Topcon TRC-50DX, captured after pupil dilation, retinal fundus photograph, 50° field of view: 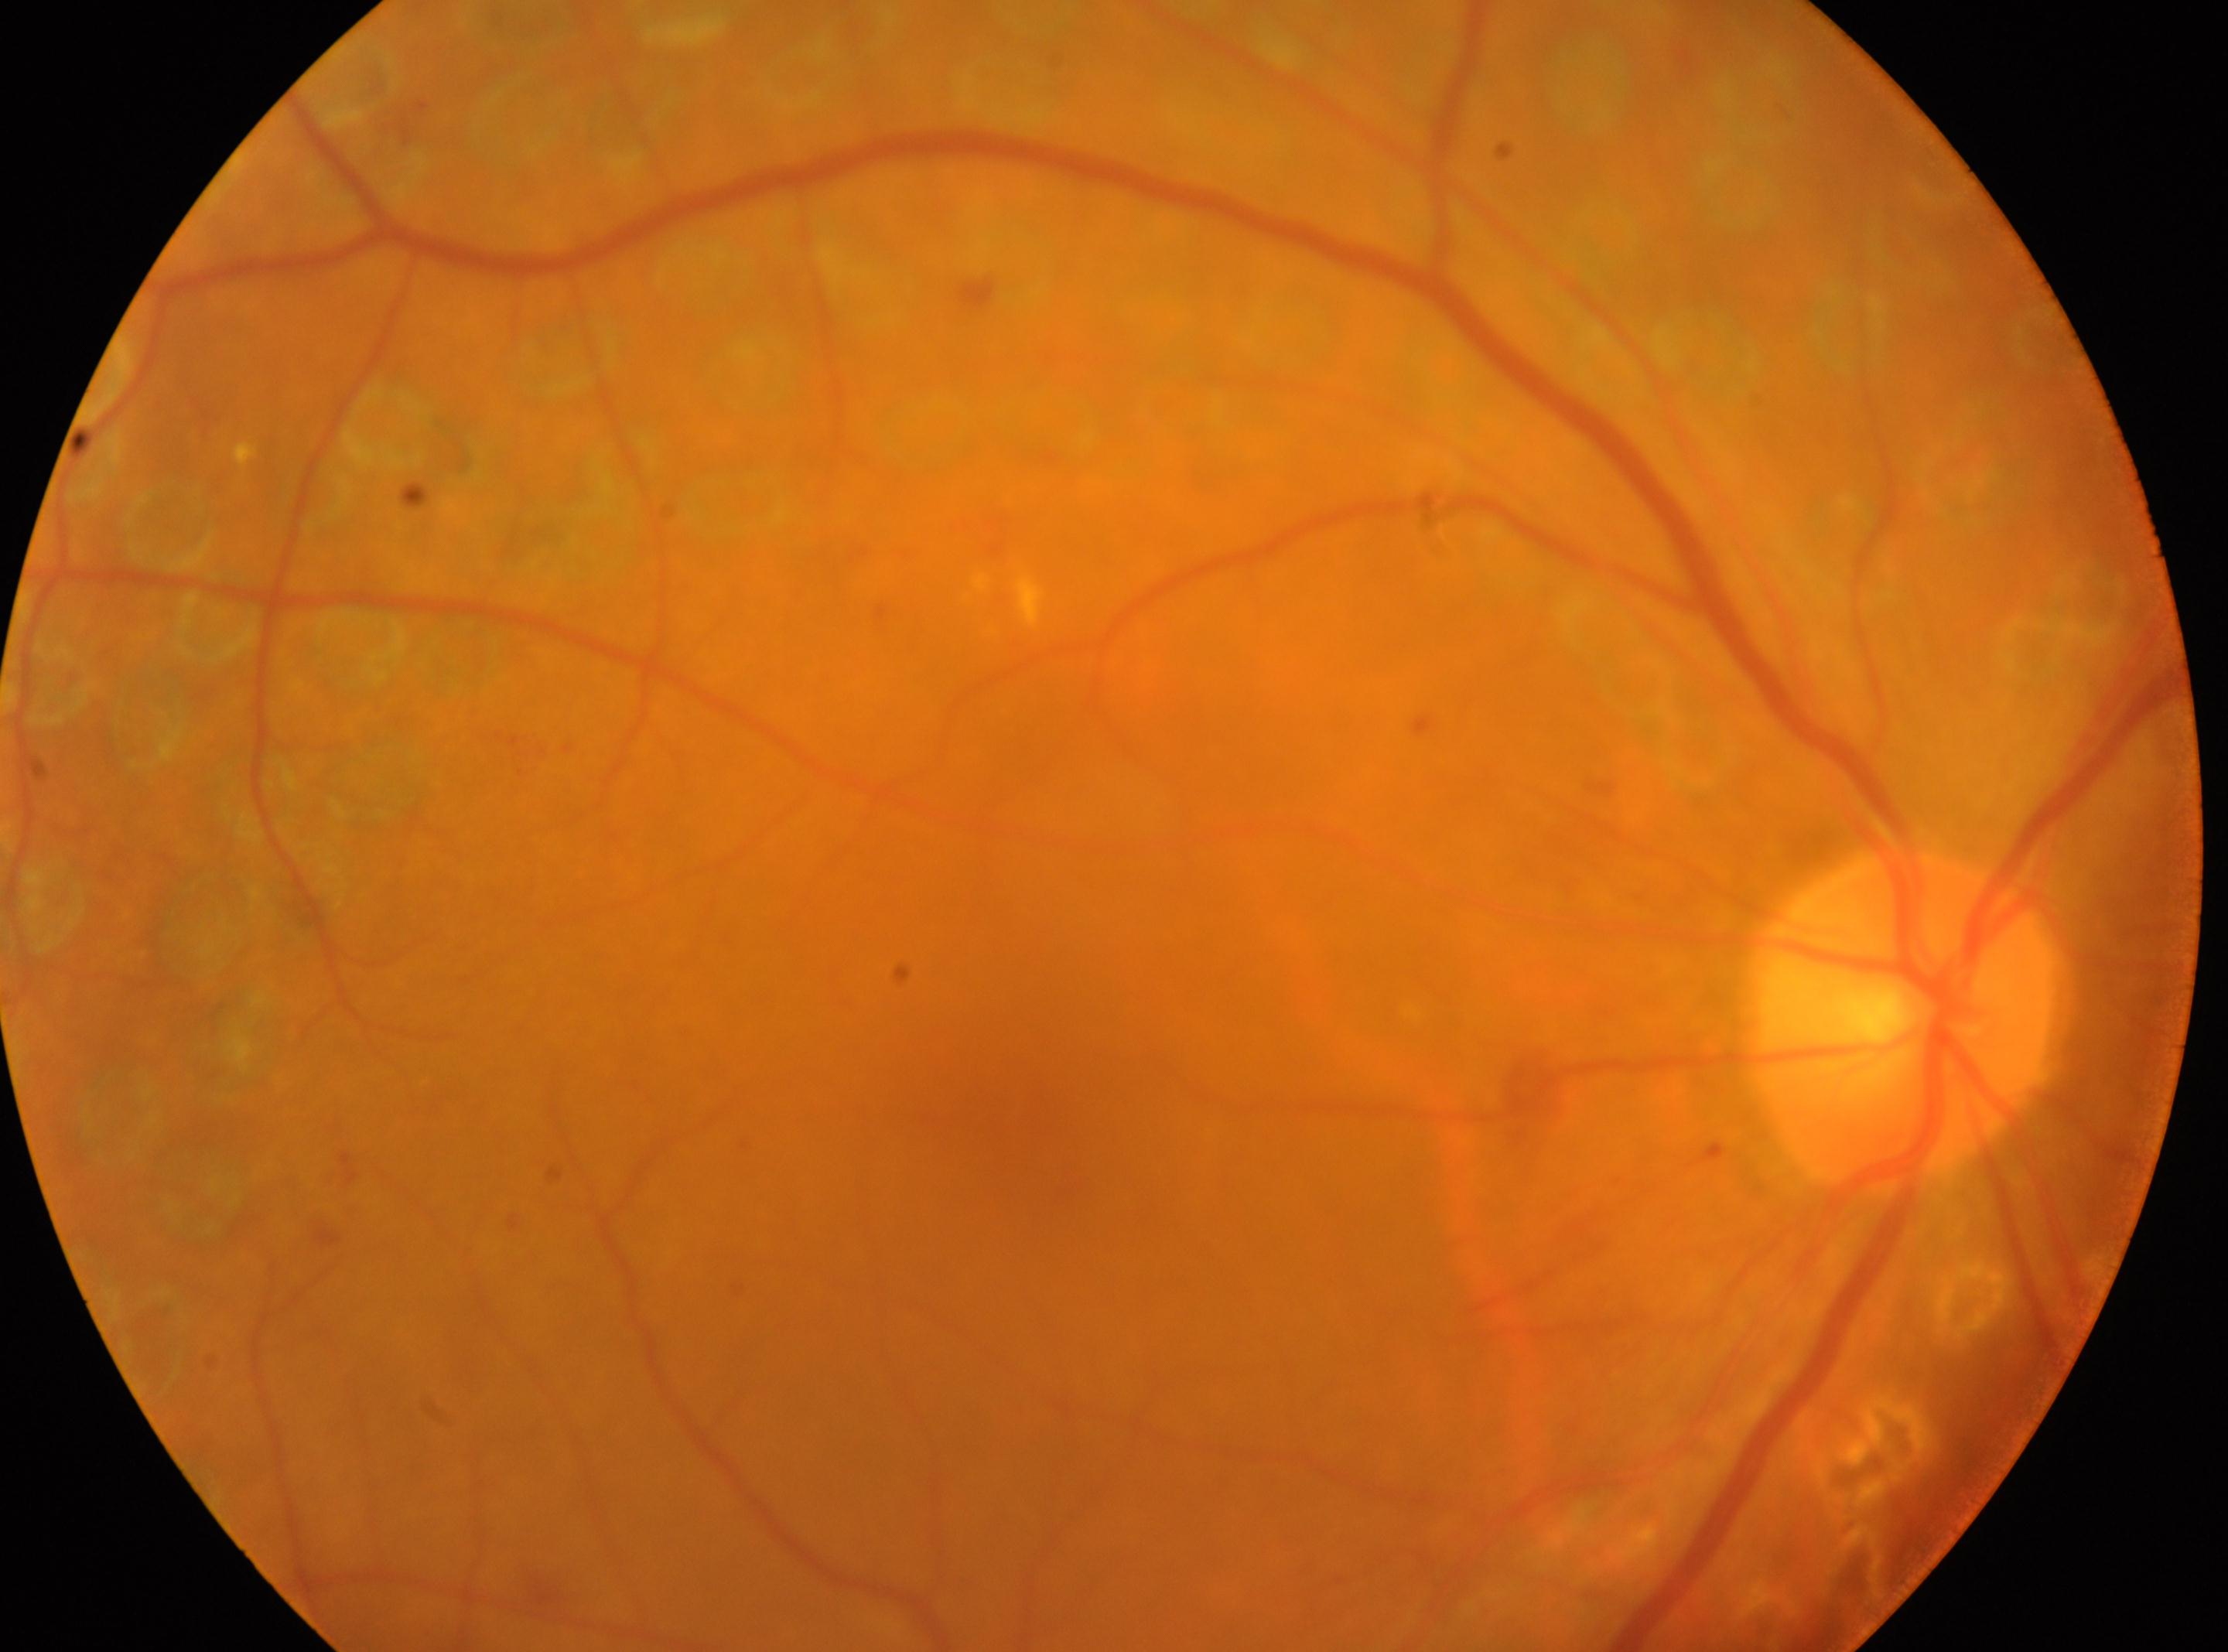
Imaged eye: right.
The macula center is at x=1027, y=1123.
ONH: x=1900, y=1022.
Diabetic retinopathy (DR): laser-treated DR.